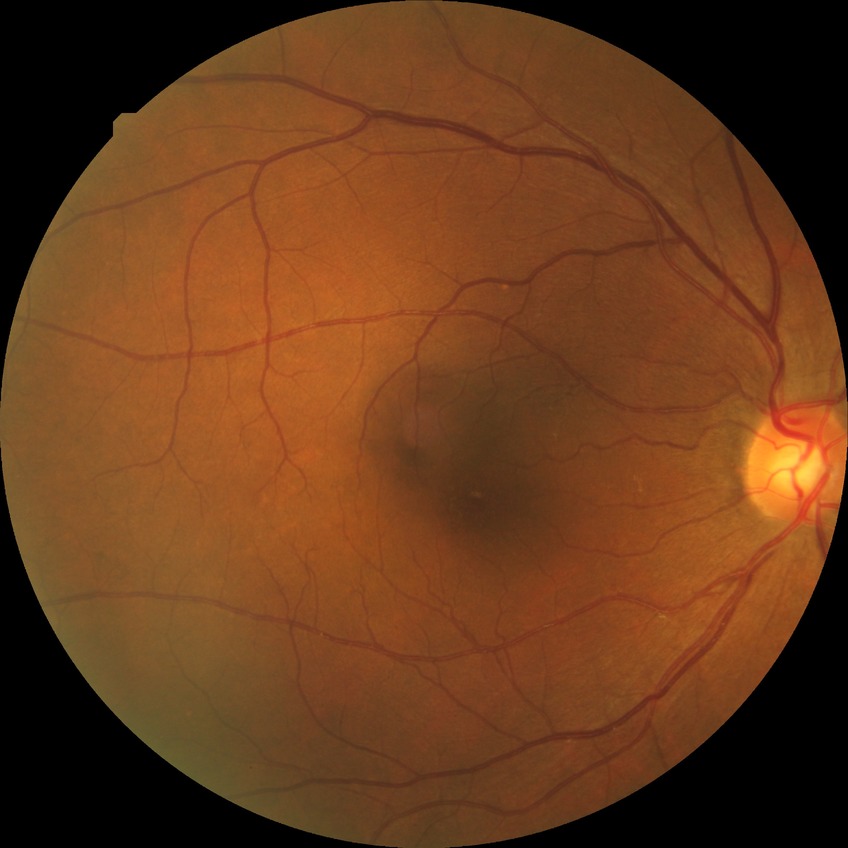

Diabetic retinopathy (DR) is no diabetic retinopathy (NDR).